Wide-field contact fundus photograph of an infant · 1440x1080px:
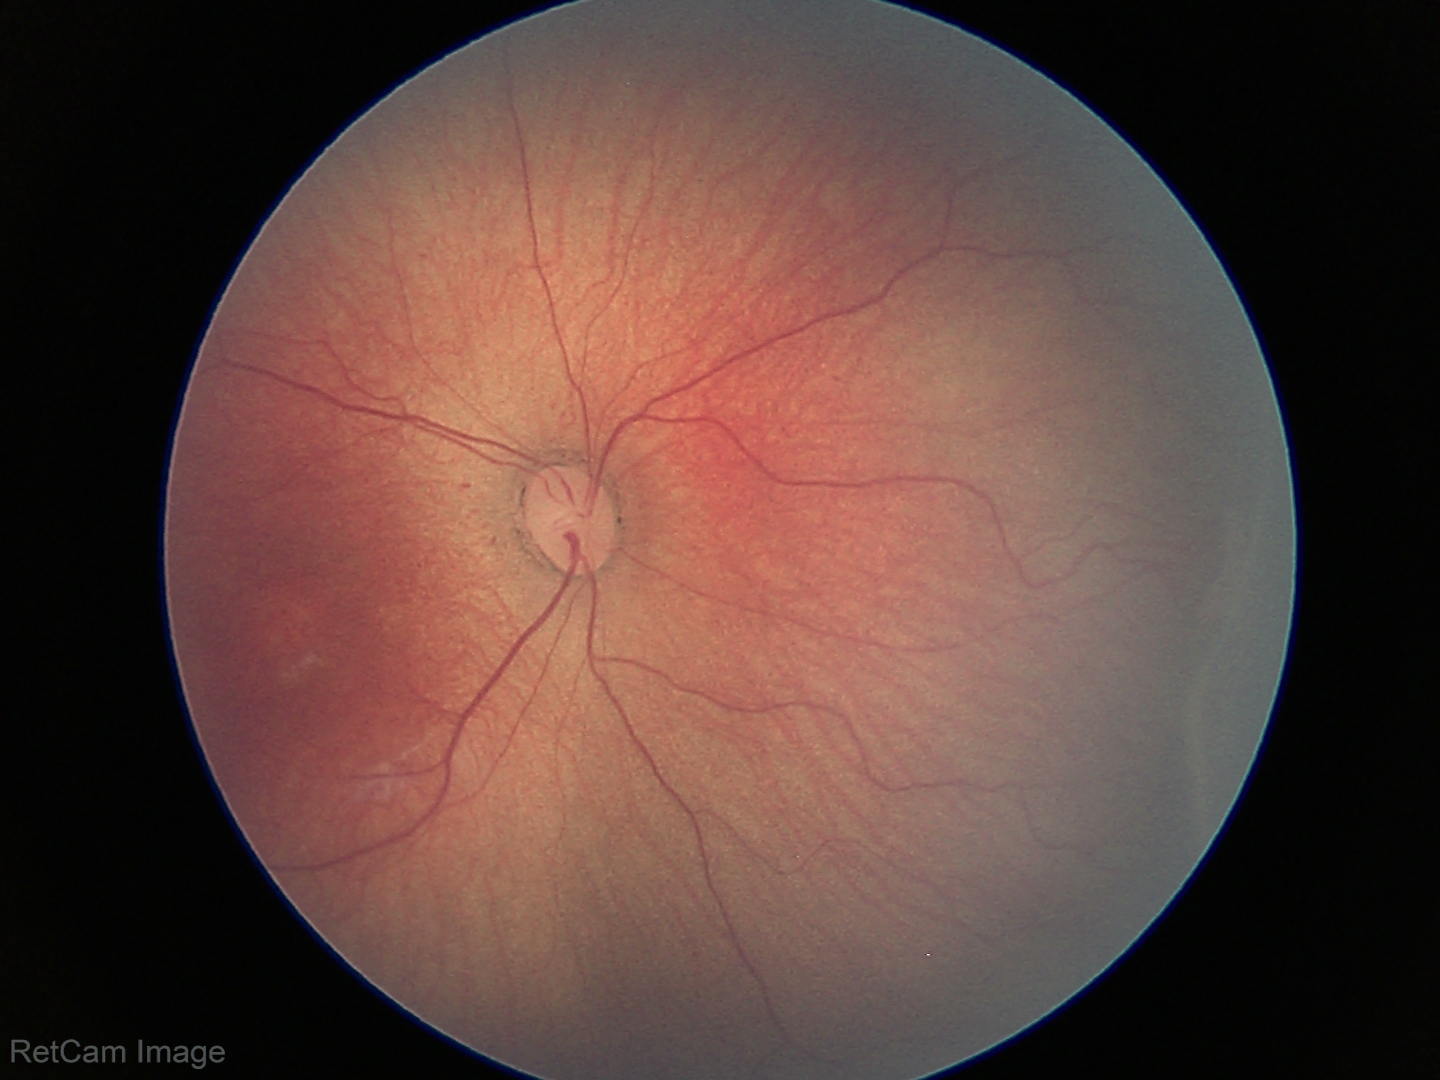

Screening: retinopathy of prematurity stage 2; no plus disease.